Color fundus image: 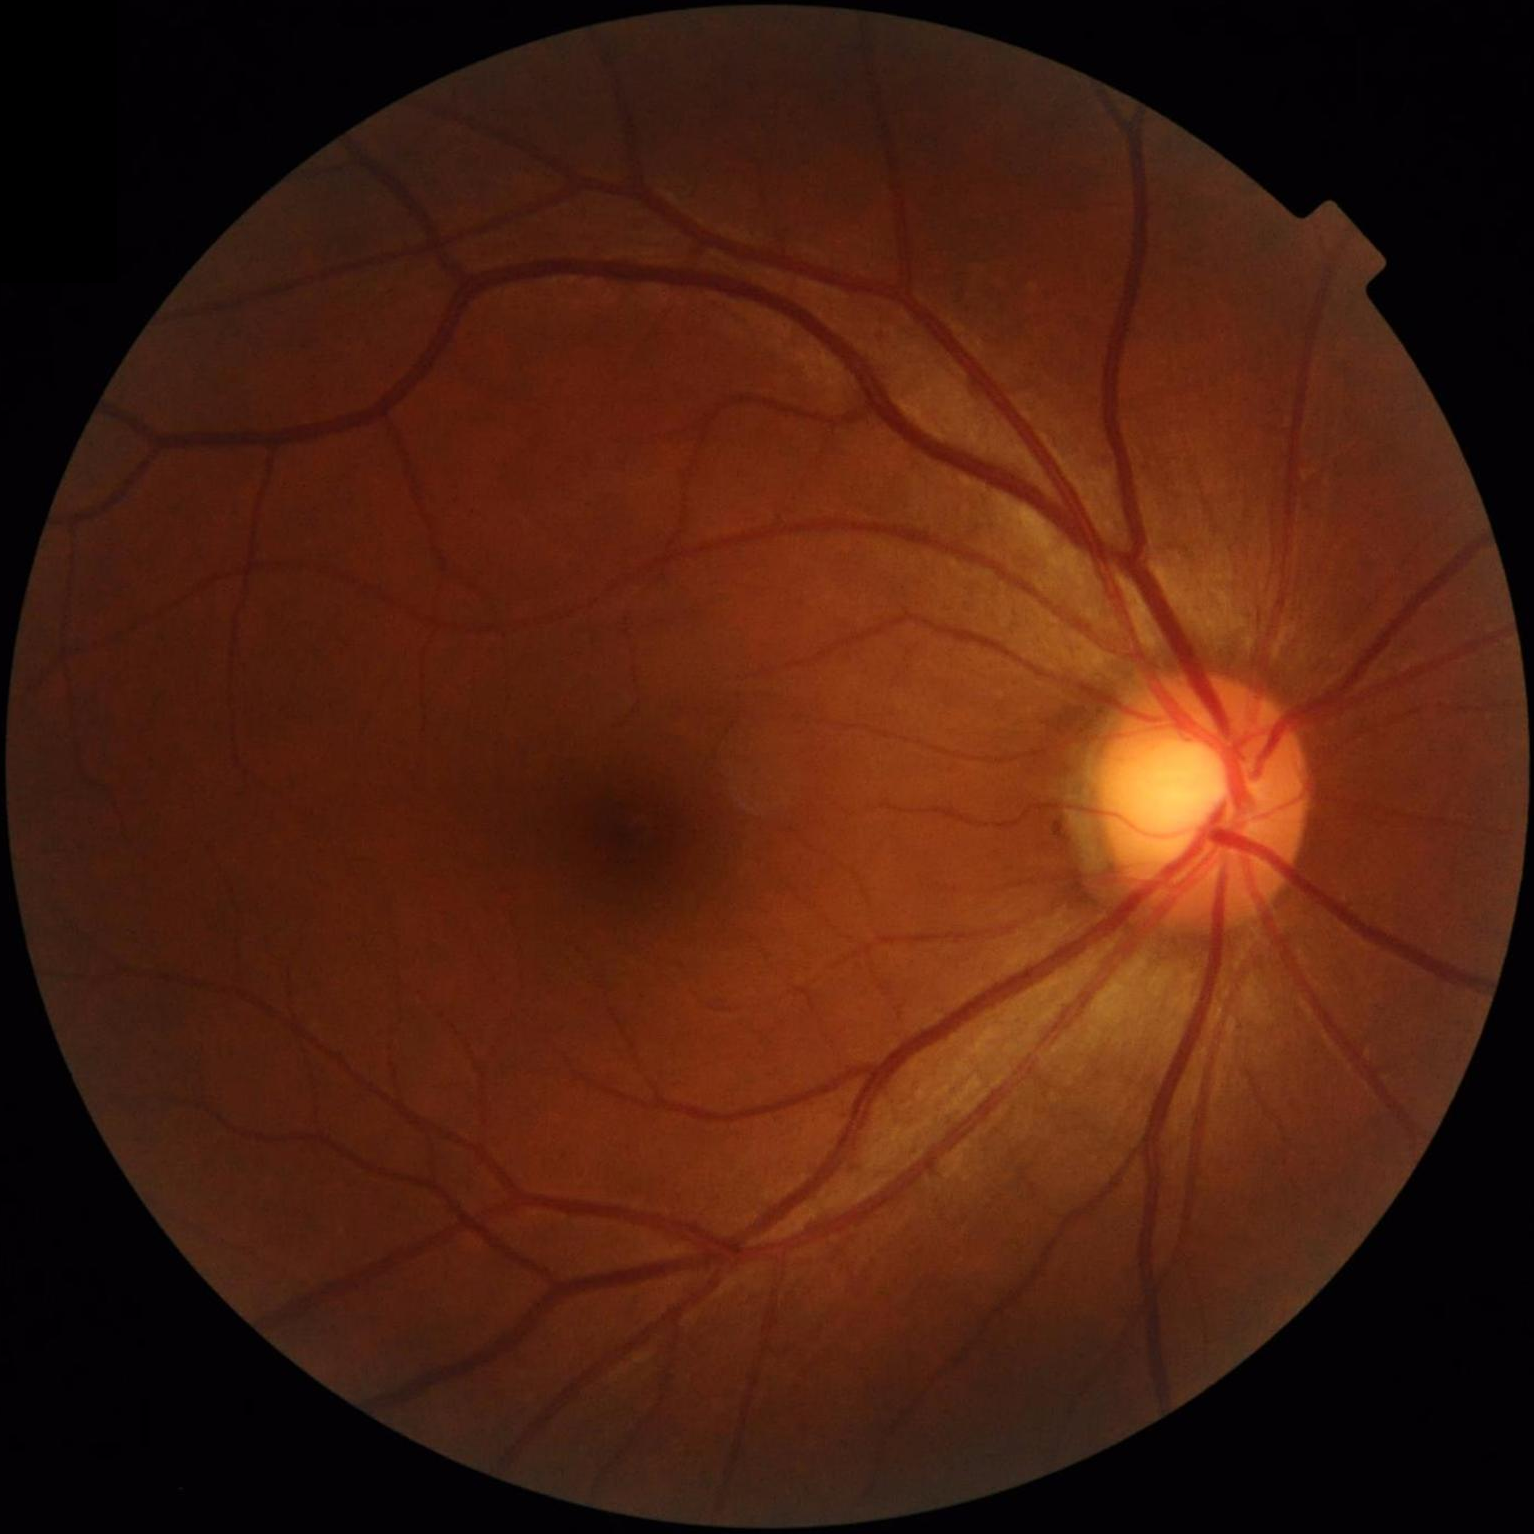
{
  "contrast": "wide intensity range, structures distinguishable",
  "clarity": "clear with no noticeable blur"
}